640 by 480 pixels · pediatric retinal photograph (wide-field):
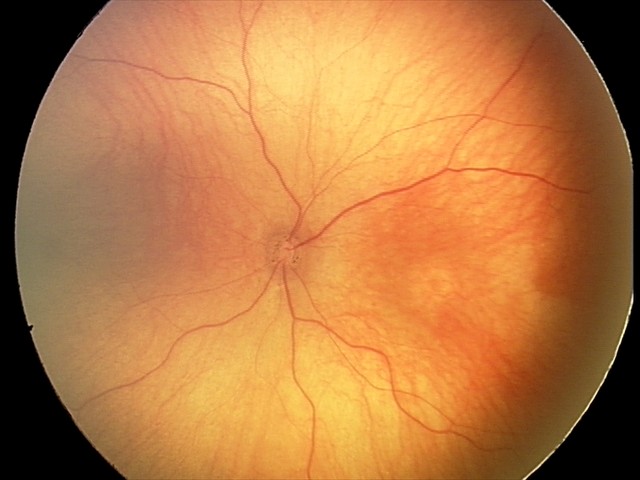

Screening examination consistent with optic nerve hypoplasia.